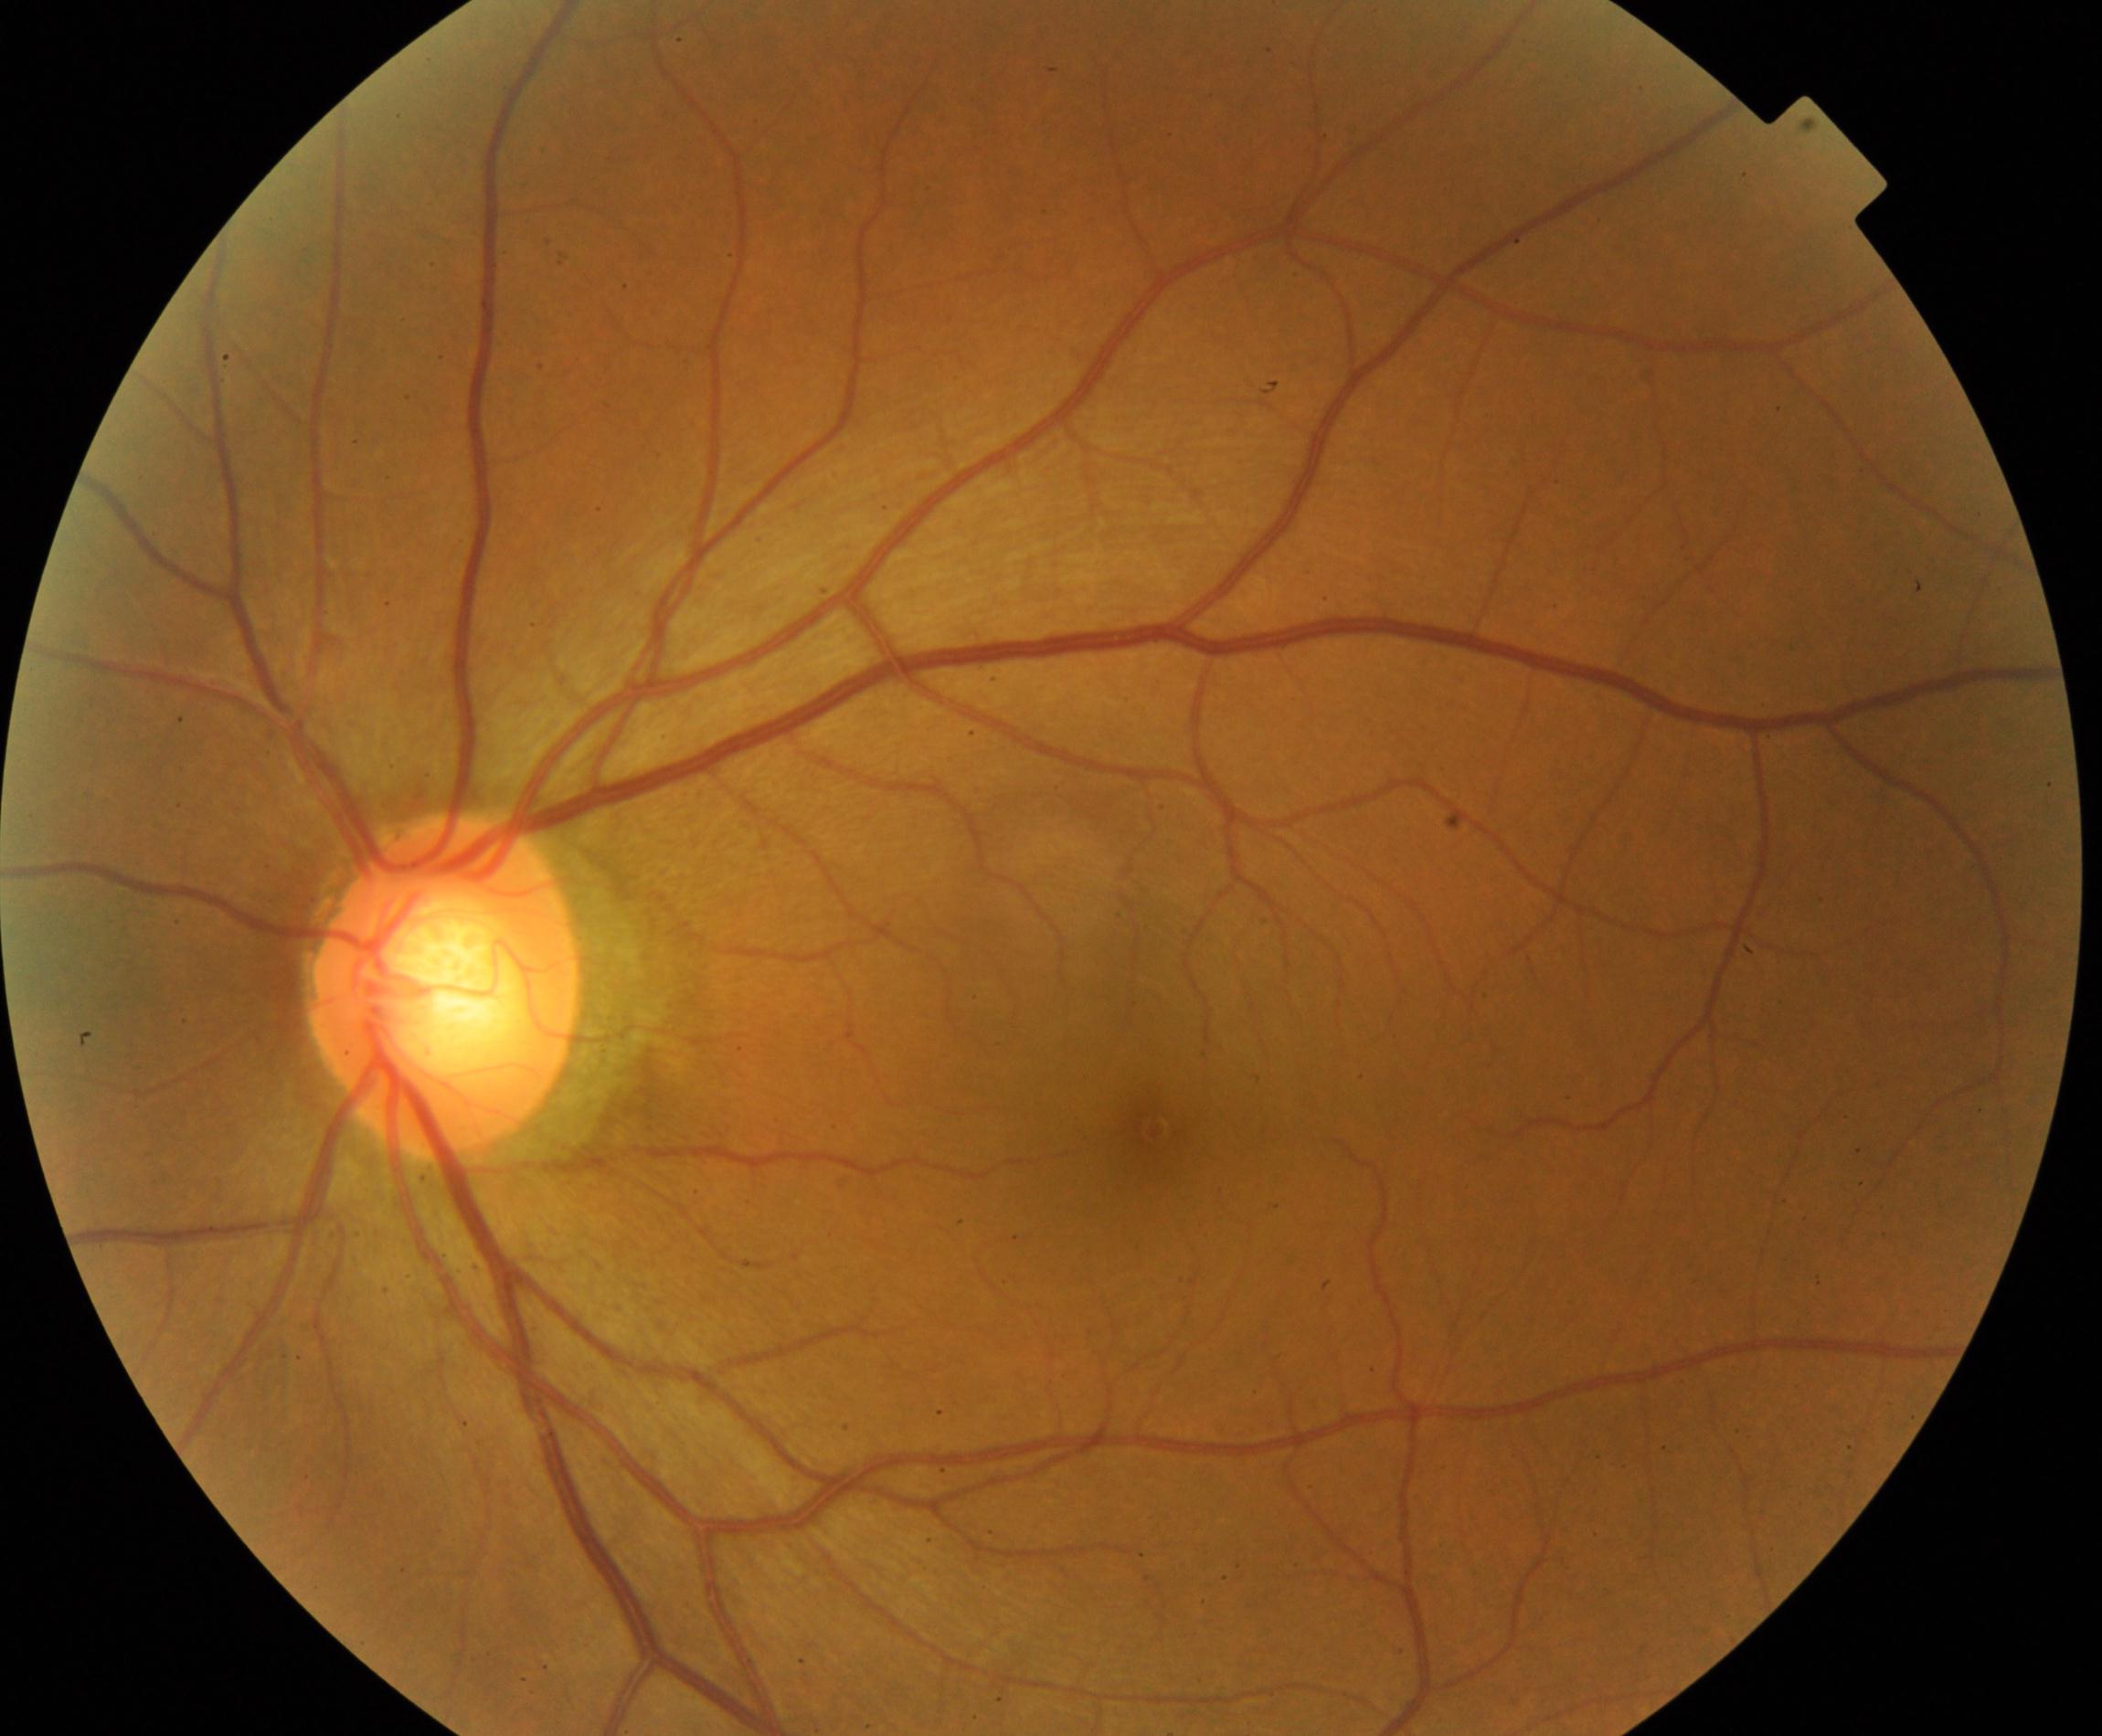

There is evidence of large optic cup. Characterized by cup-to-disc ratio greater than 0.5, with a pink neuroretinal rim following the ISNT rule, without notching or bayoneting of vessels.